Image size 1240x1240; Phoenix ICON, 100° FOV; pediatric retinal photograph (wide-field): 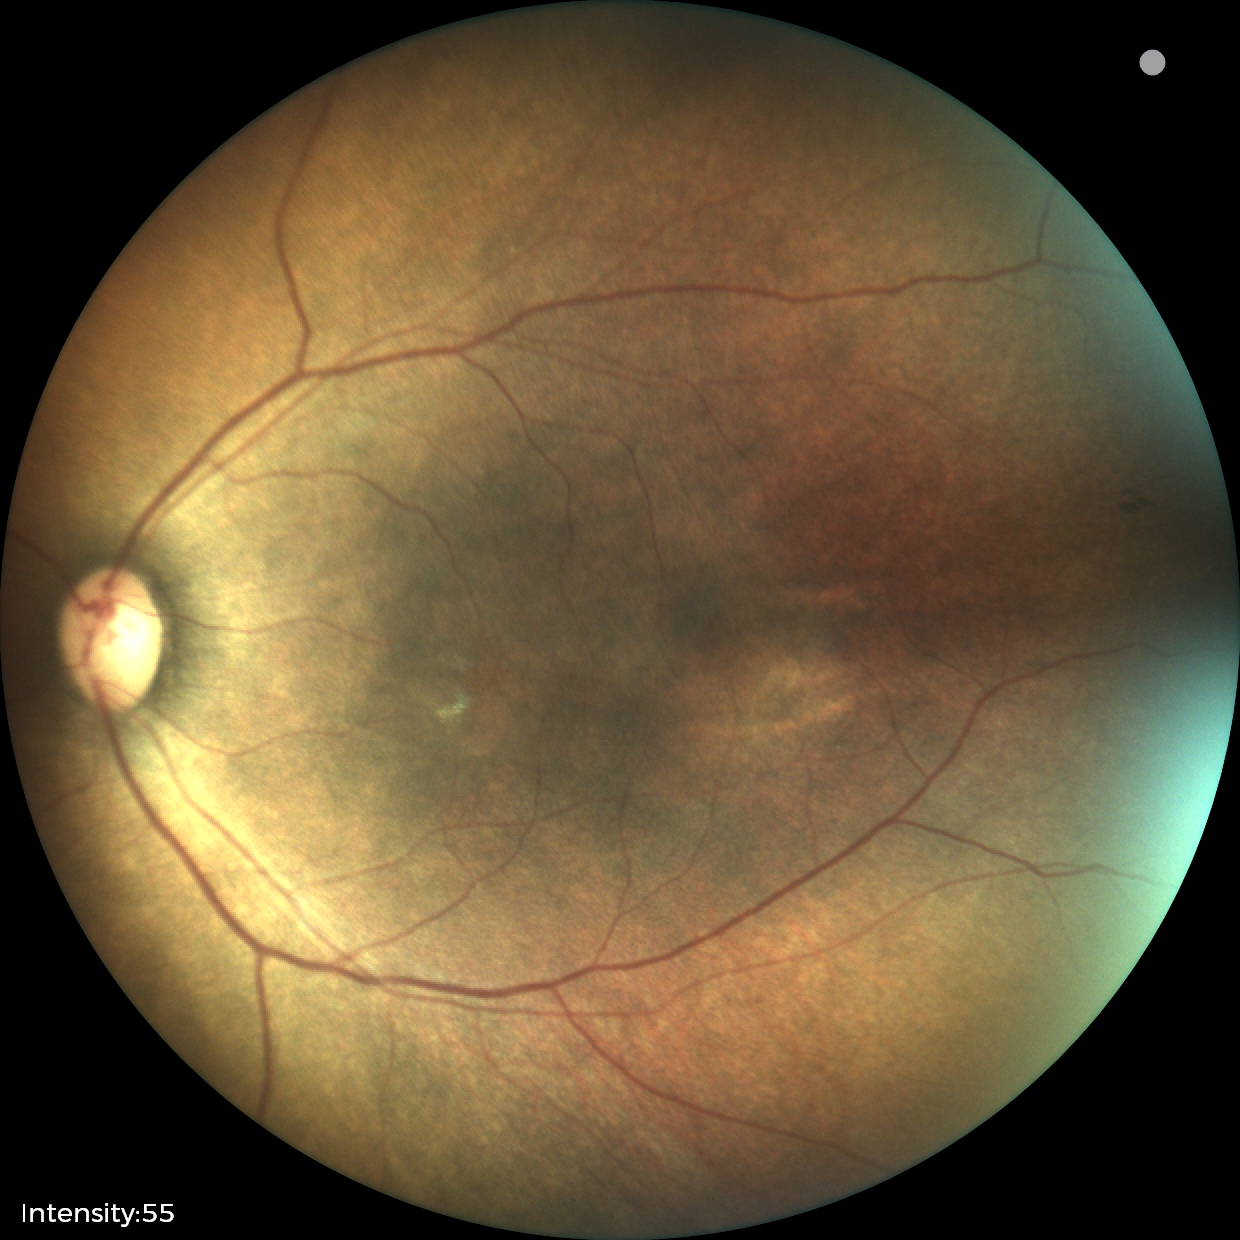
Finding: status post ROP — retinal appearance after treated retinopathy of prematurity | plus disease: absent.